Without pupil dilation; posterior pole color fundus photograph
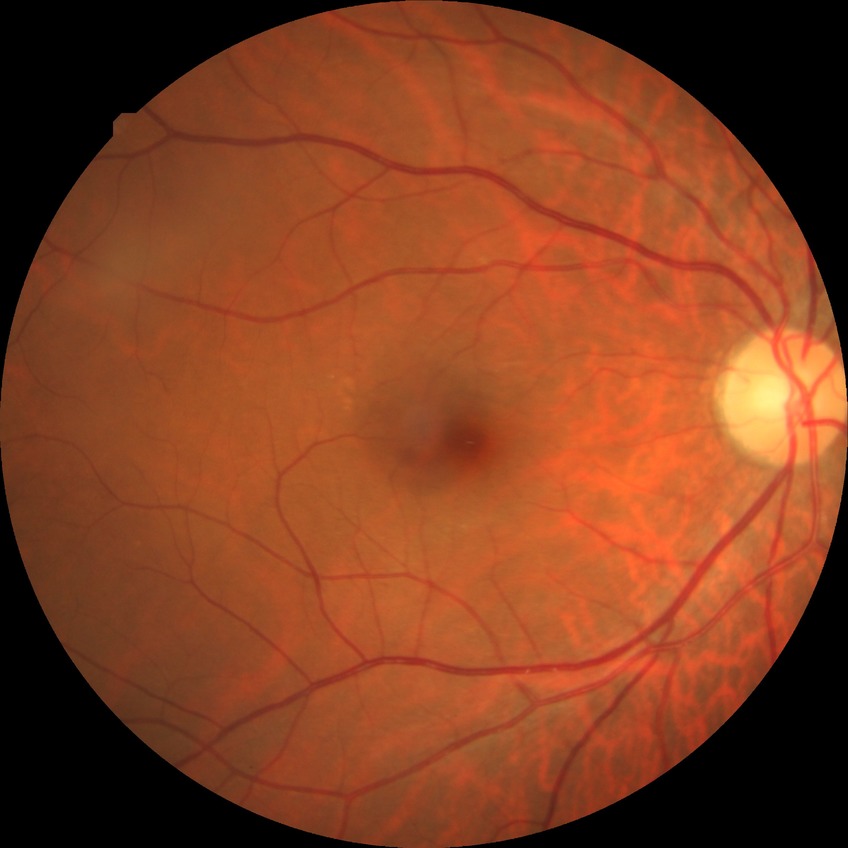 diabetic retinopathy (DR): NDR (no diabetic retinopathy).